640x480px; RetCam wide-field infant fundus image; acquired on the Clarity RetCam 3:
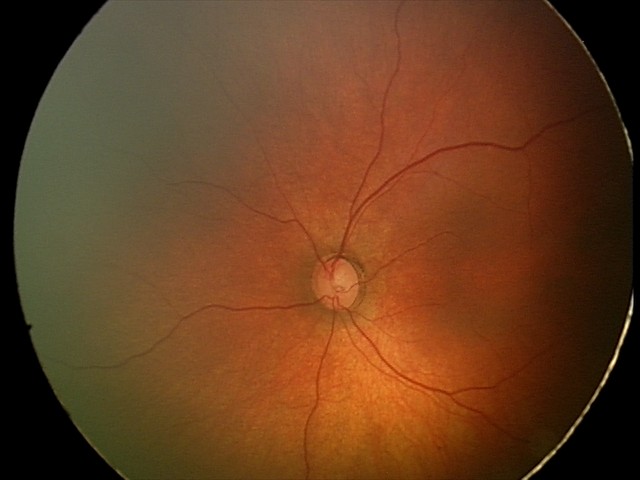
Screening examination with no abnormal retinal findings.